Wide-field fundus image from infant ROP screening. Image size 1240x1240.
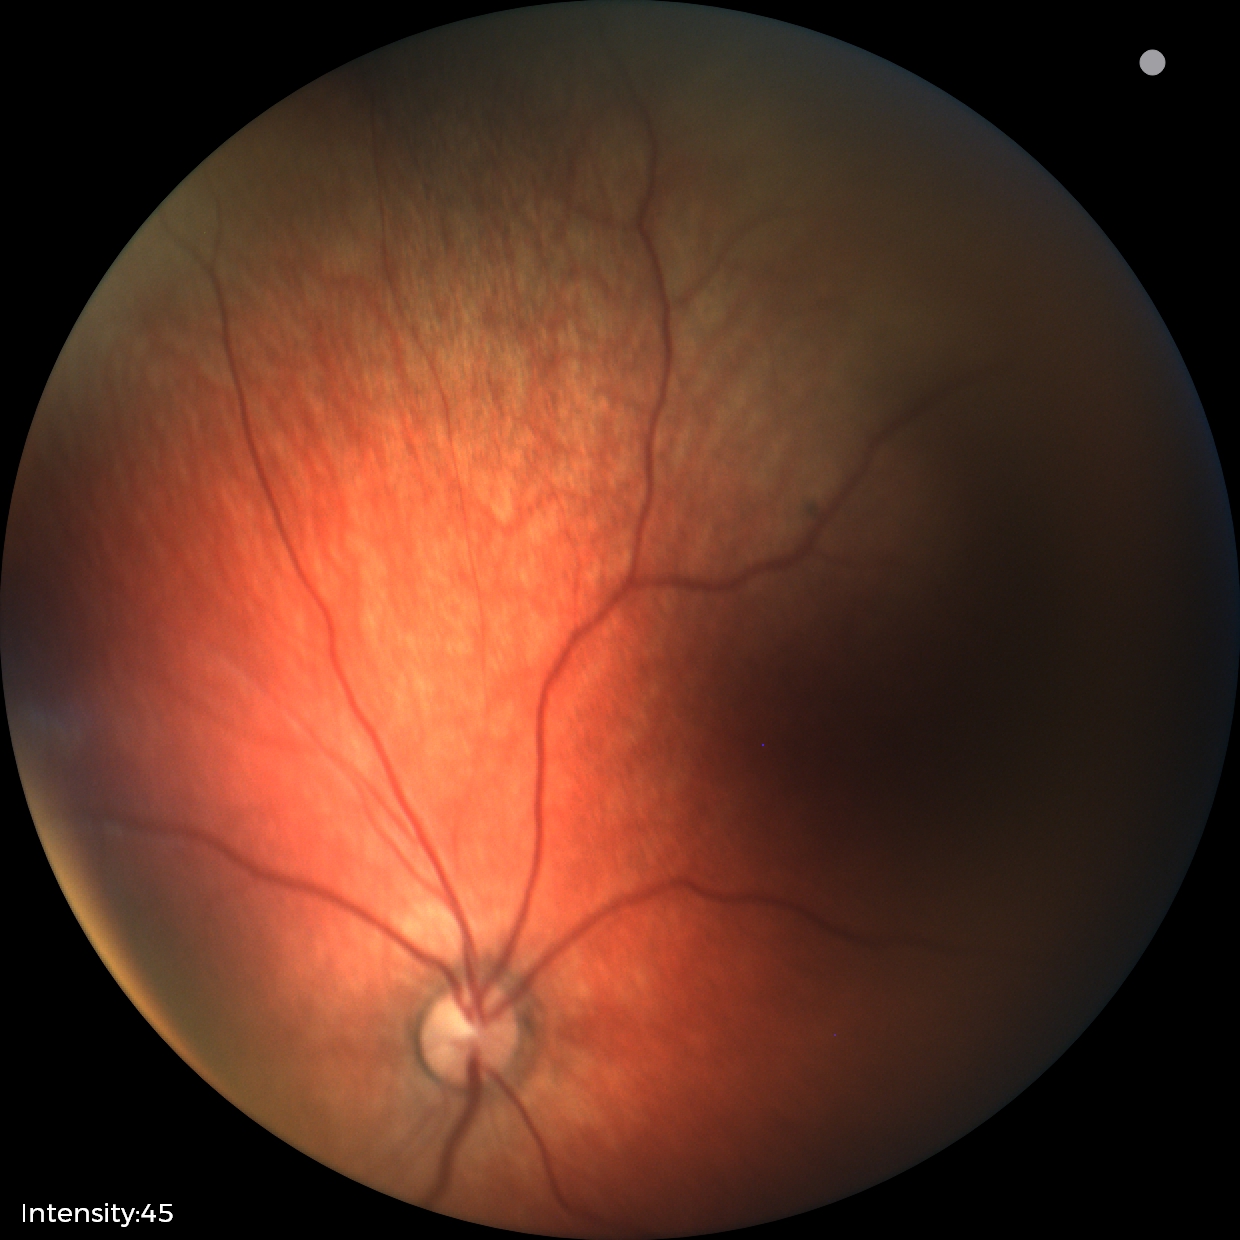
Assessment = physiological